Color fundus photograph: 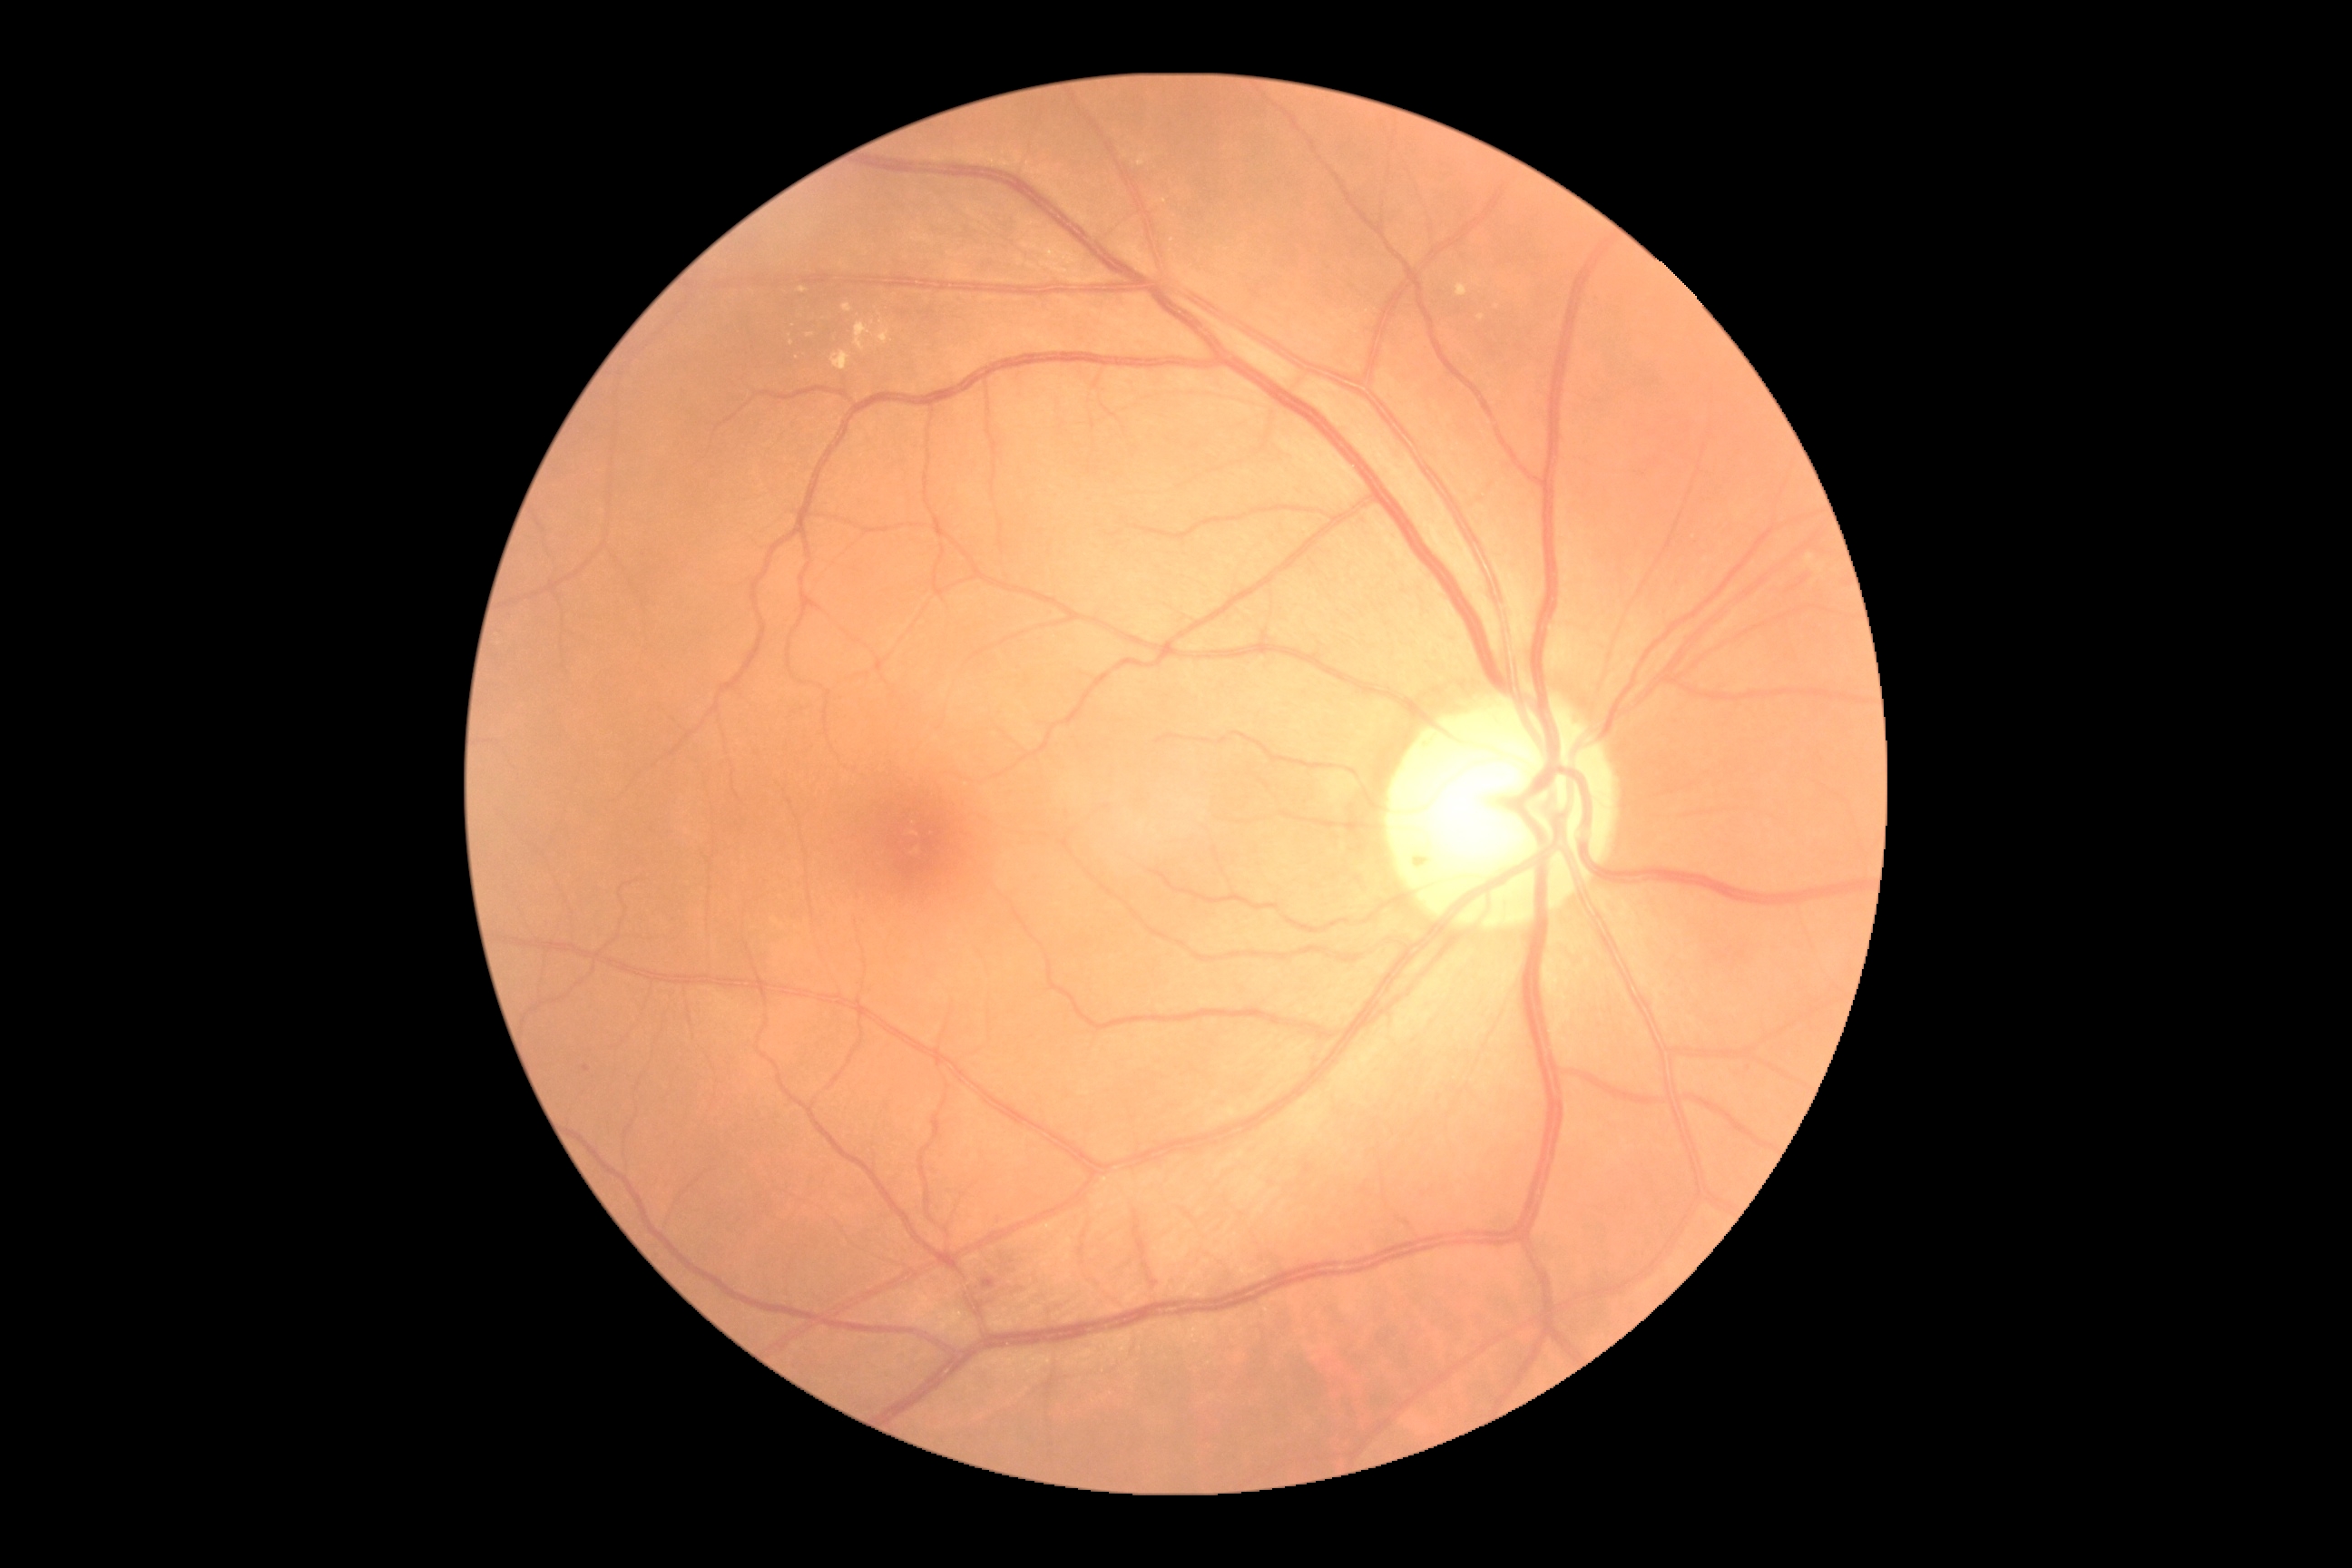

Diabetic retinopathy (DR): 2/4 — more than just microaneurysms but less than severe NPDR. DR class: non-proliferative diabetic retinopathy.